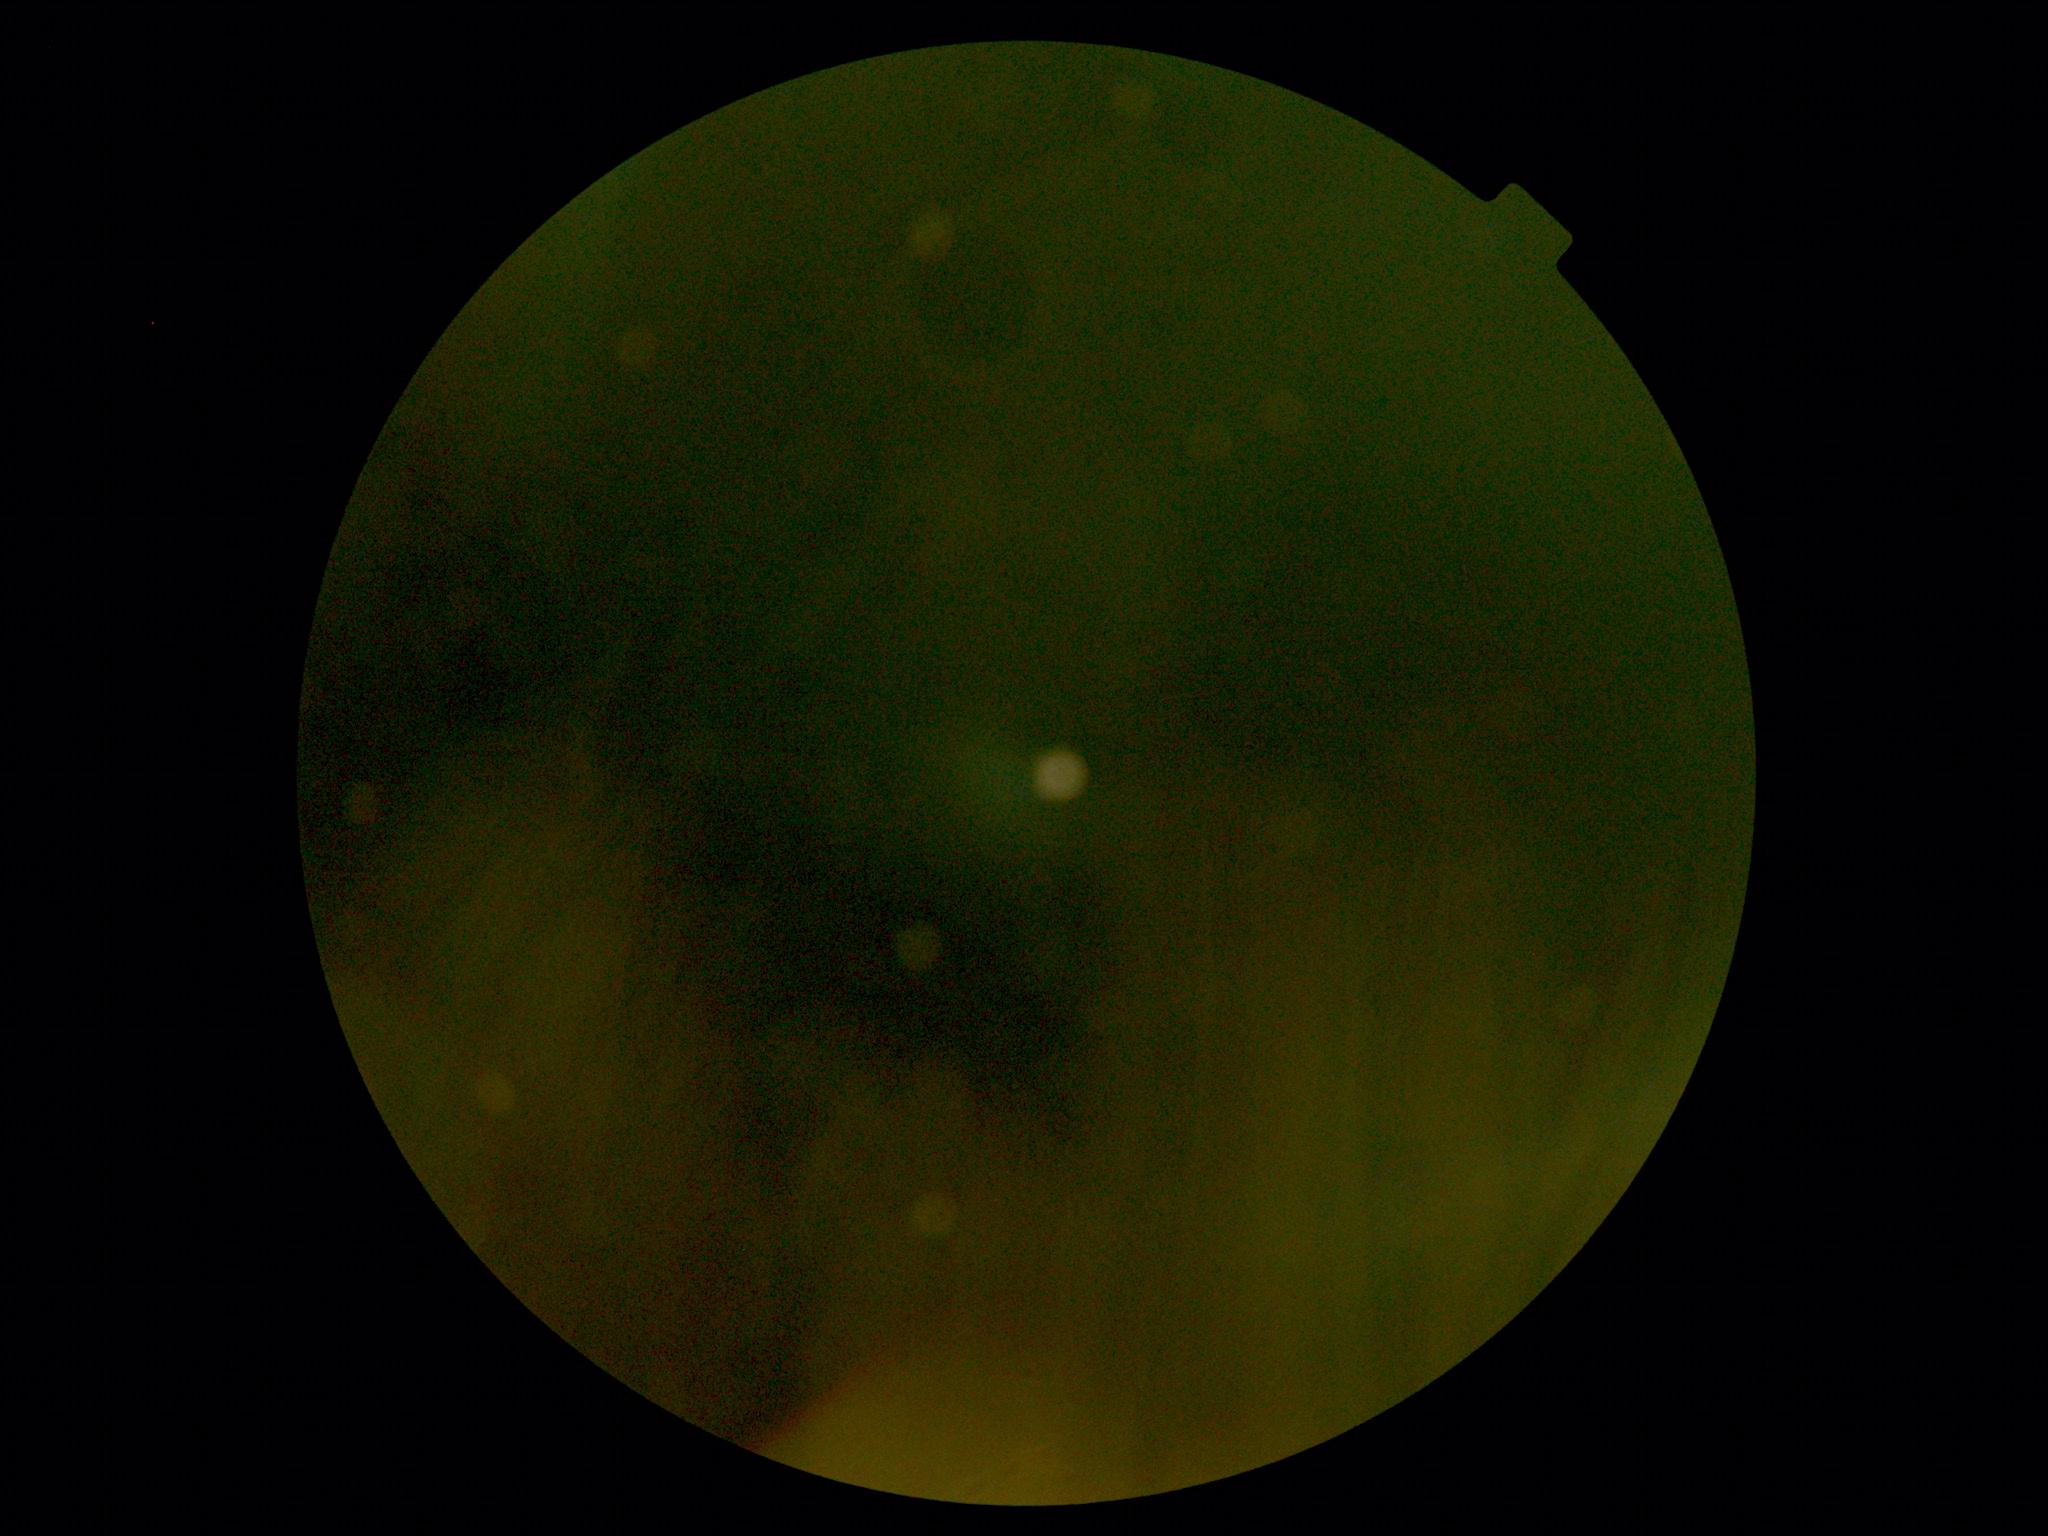

DR: ungradable; image quality: insufficient for DR assessment.